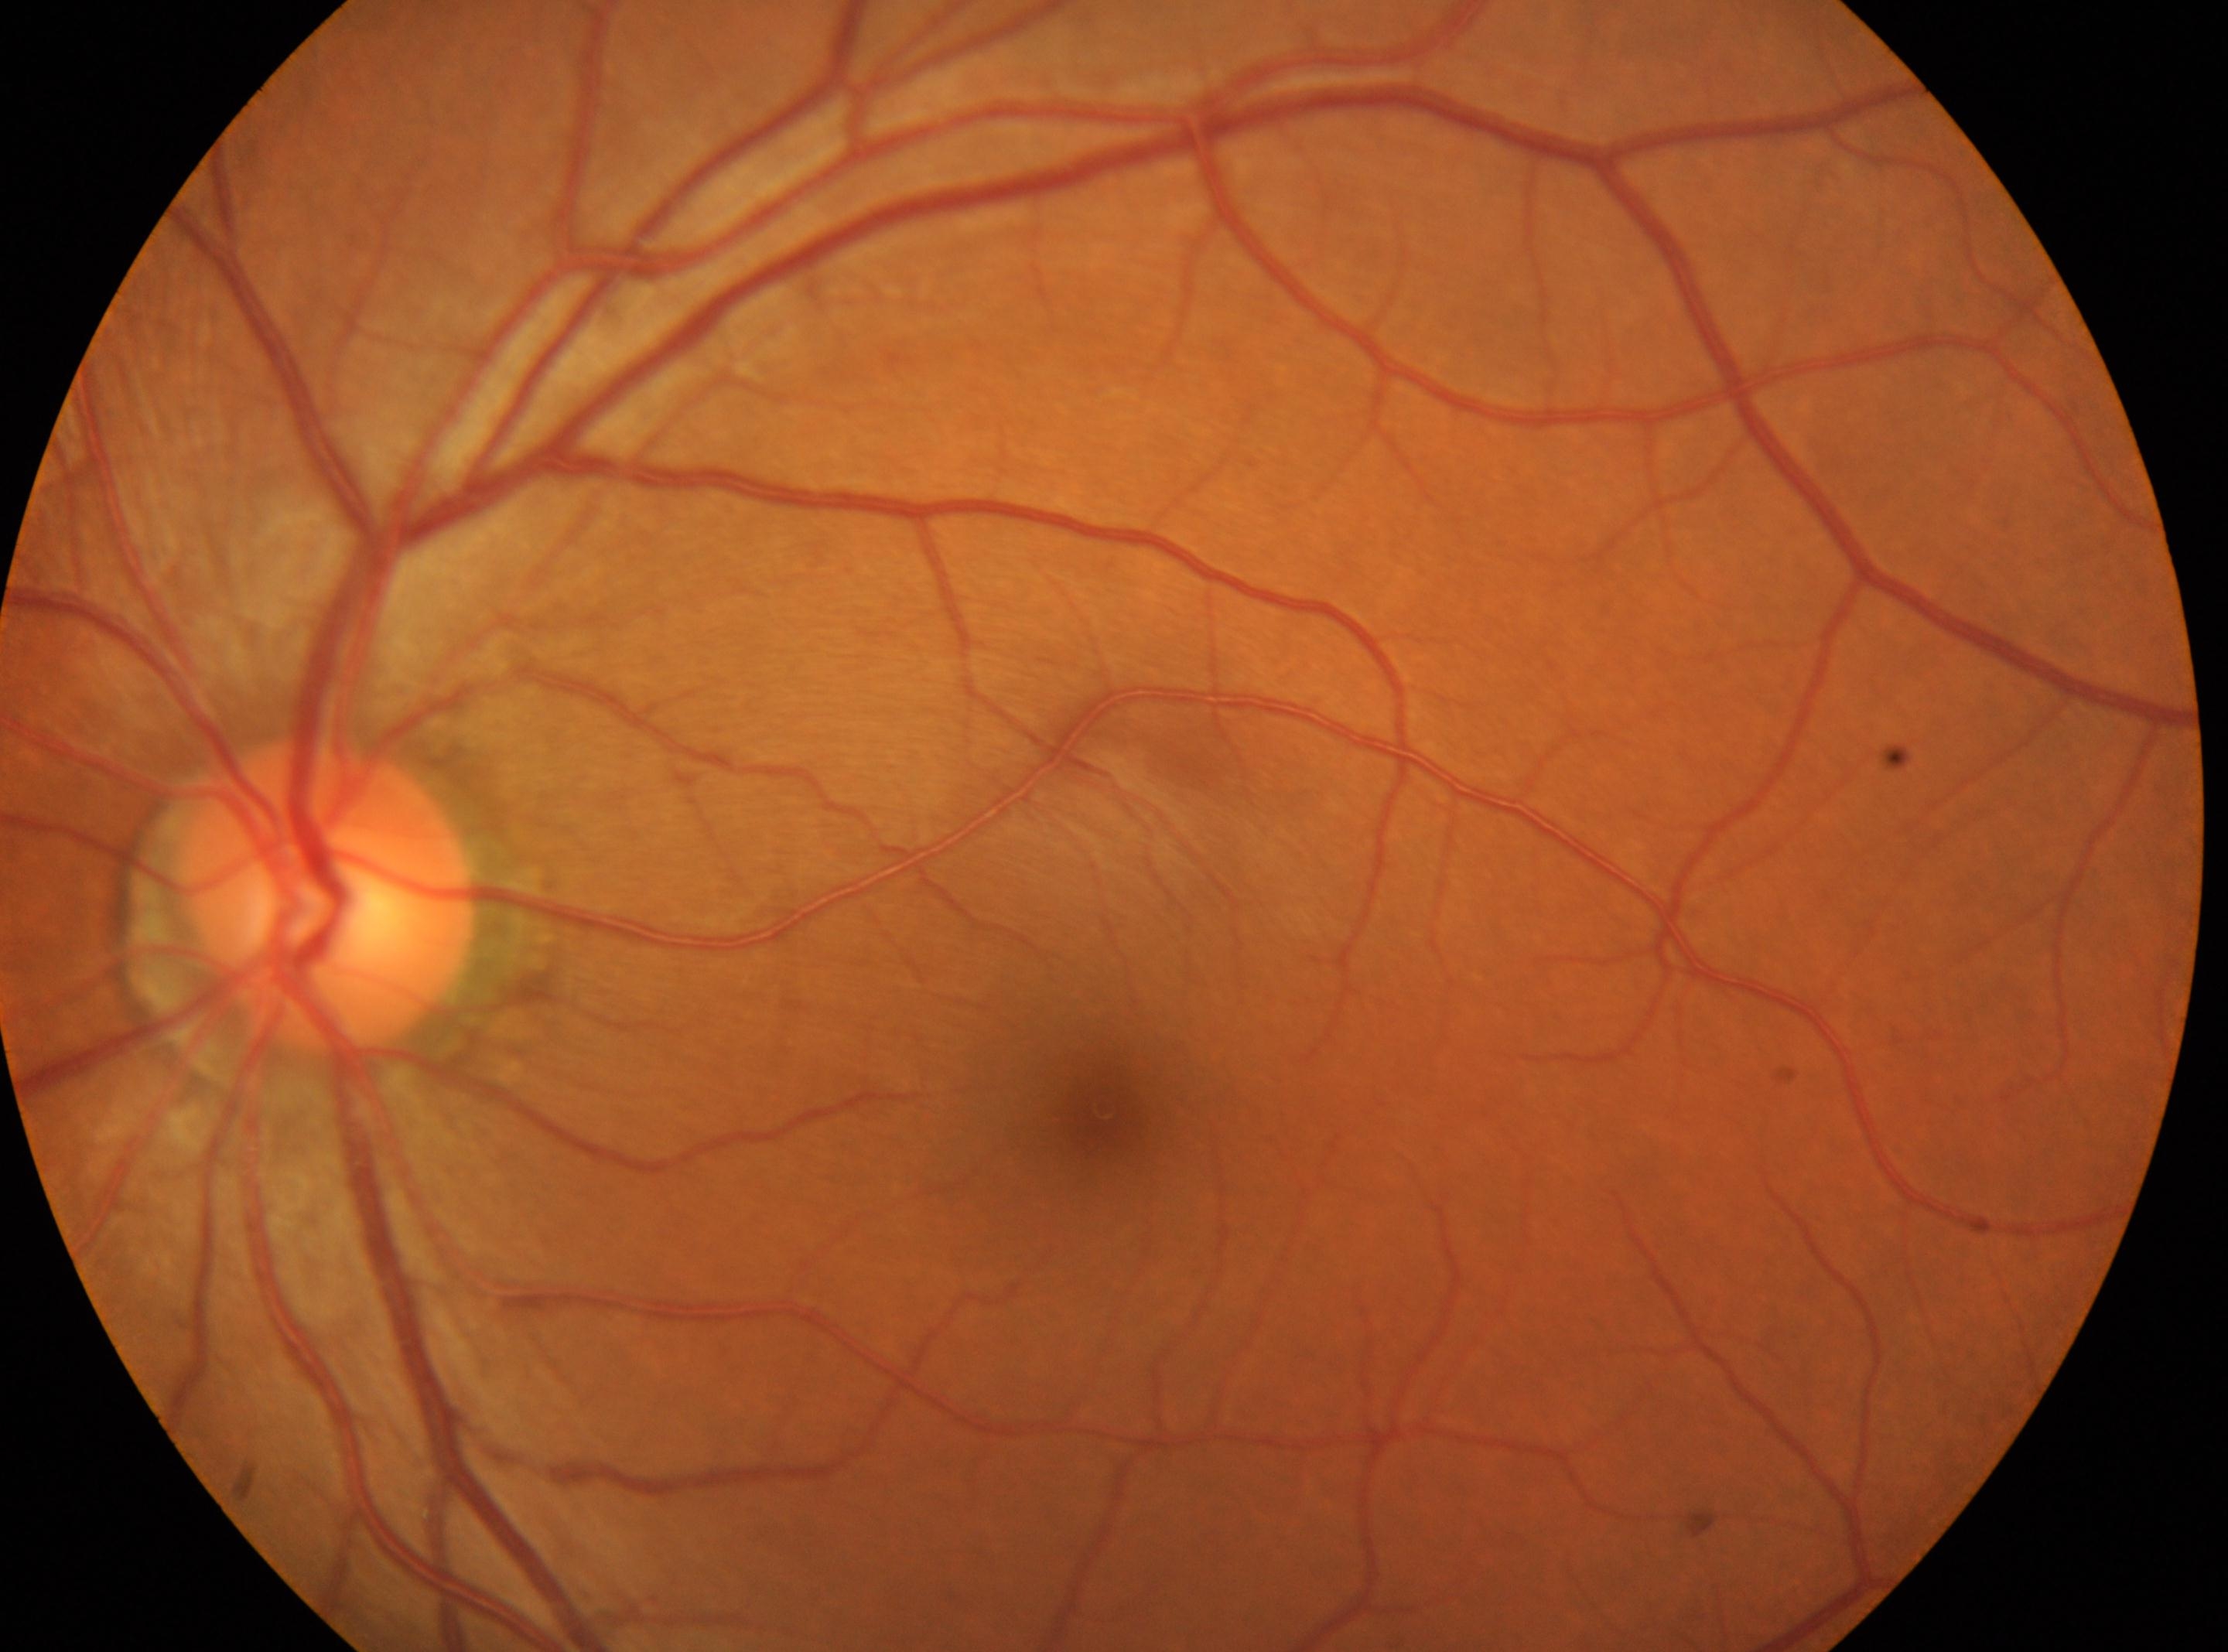
optic disc center@329px, 898px | left | fovea@1105px, 1111px | diabetic retinopathy (DR)@no apparent retinopathy (grade 0).